1659x2212px · captured on a Remidio Fundus on Phone: 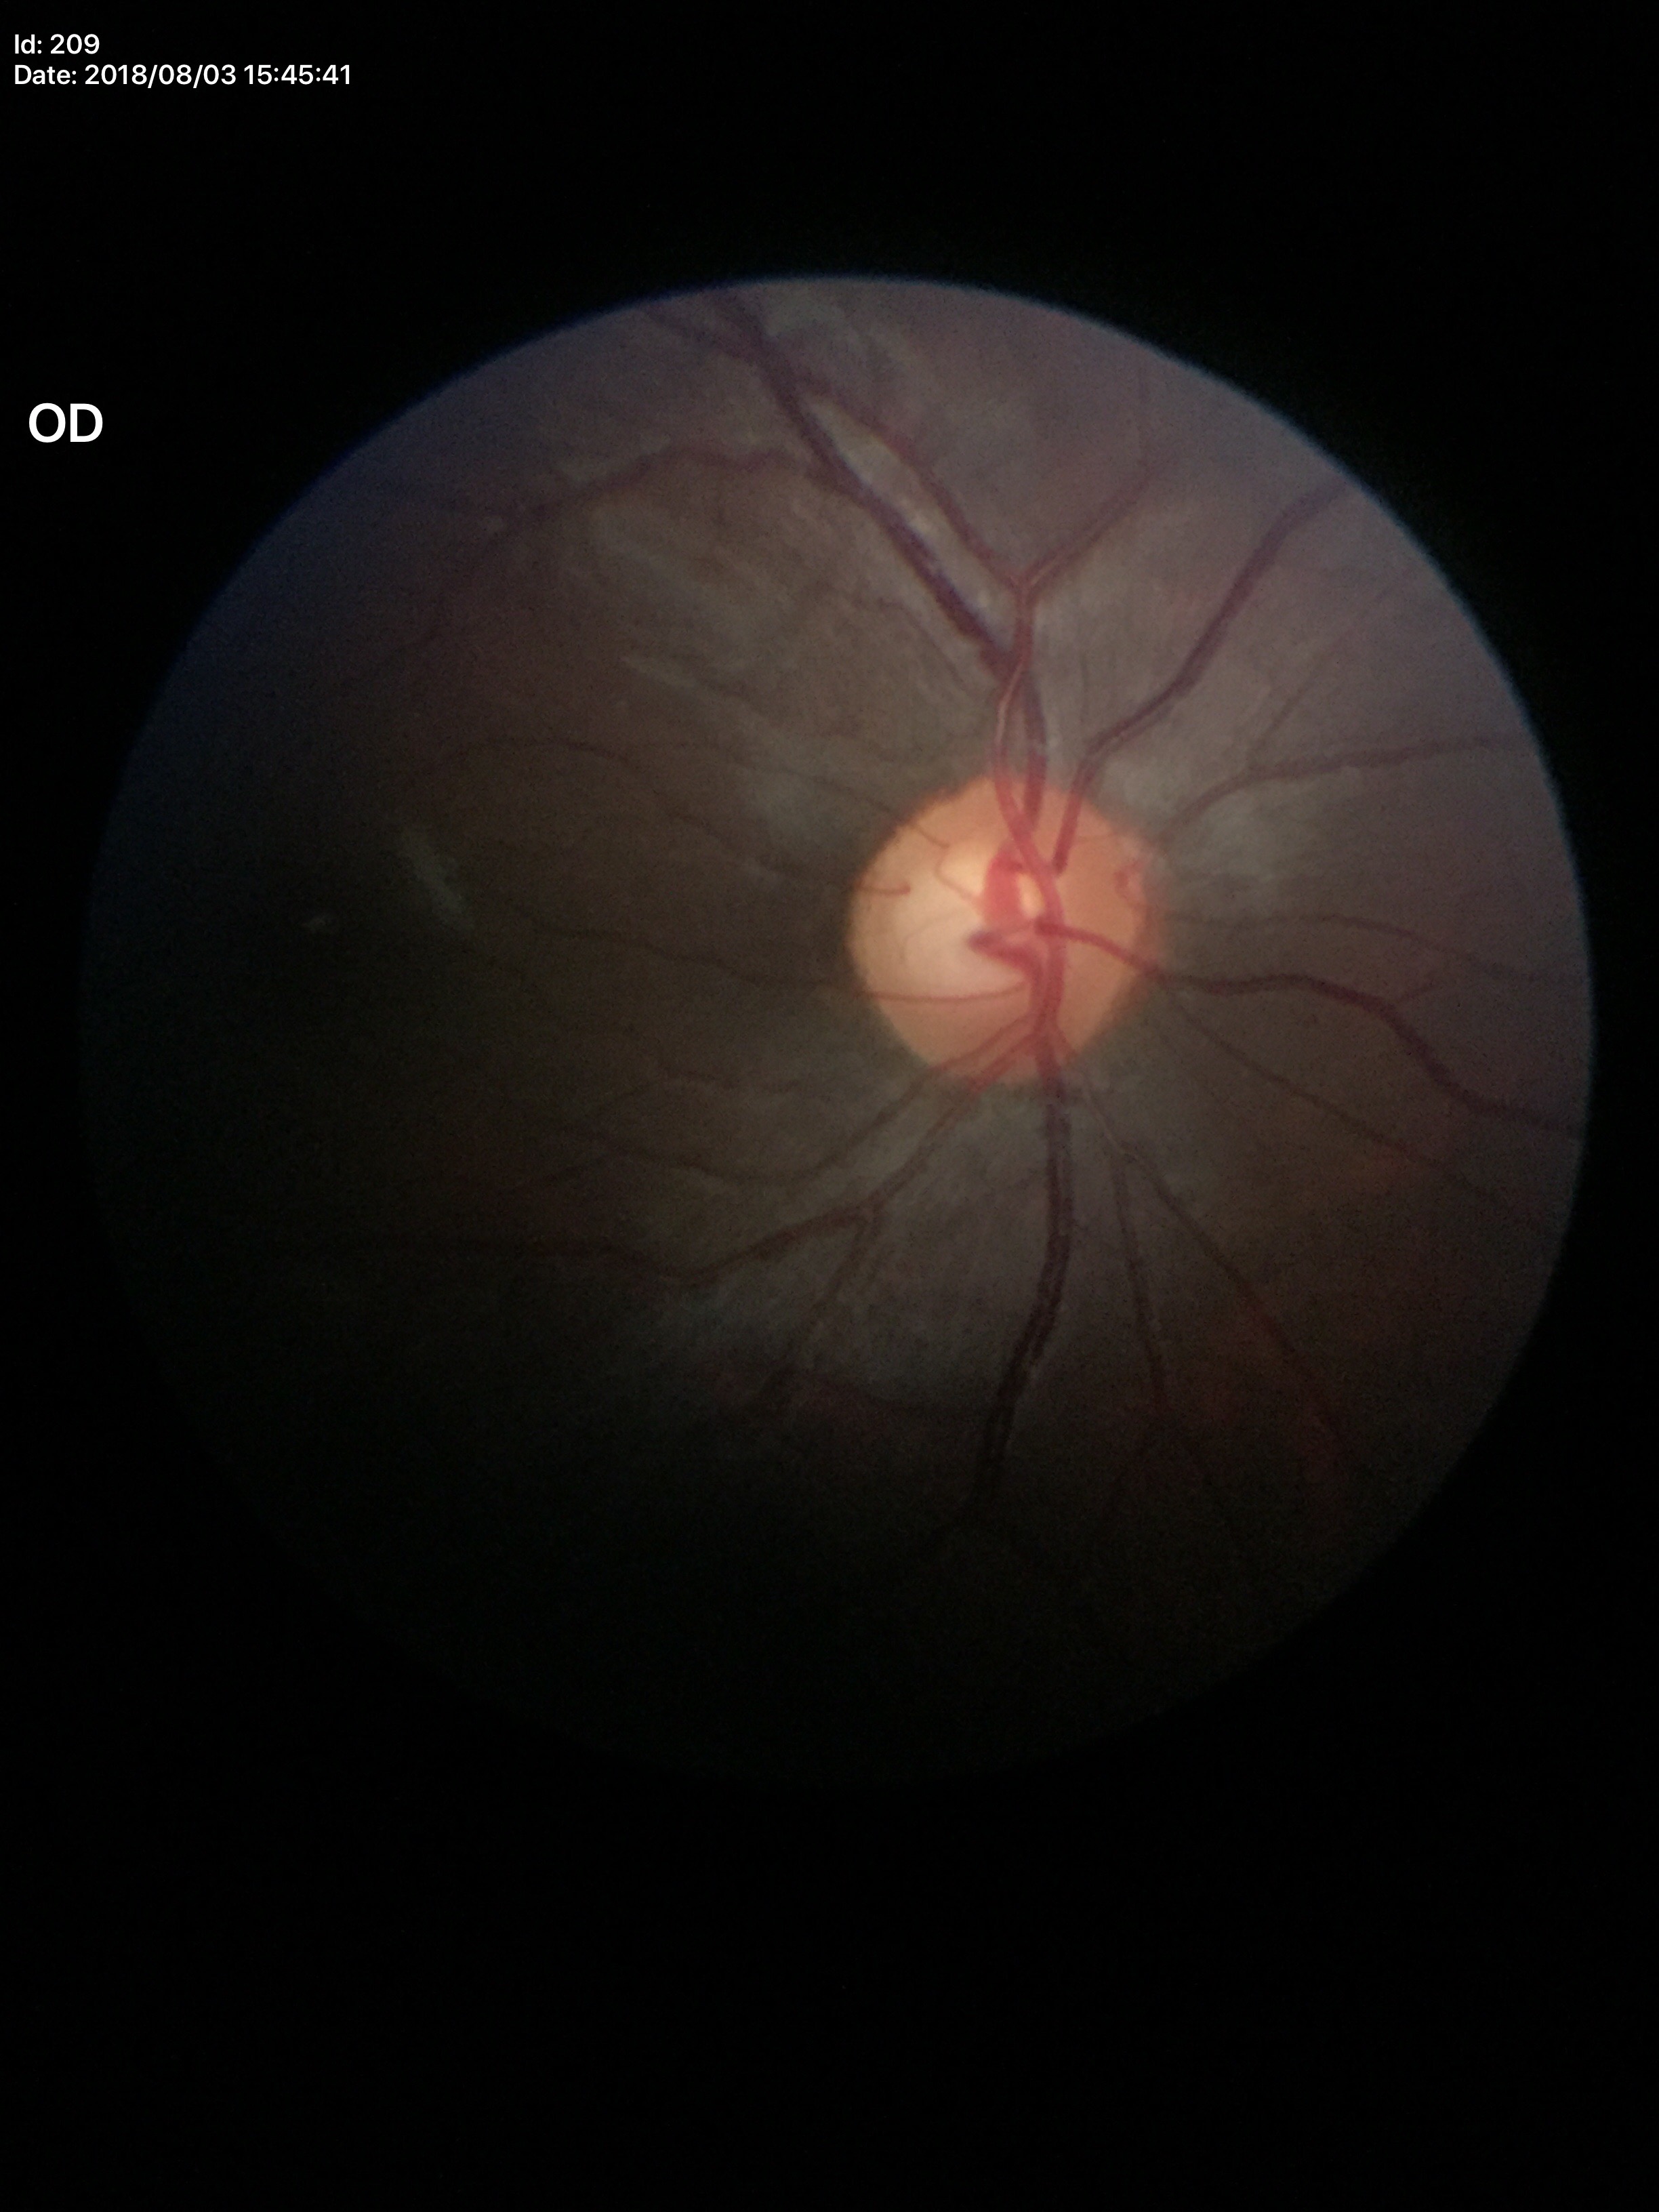
Vertical cup-disc ratio is 0.58.
Area cup-to-disc ratio: 0.36.
Negative for glaucoma suspicion.